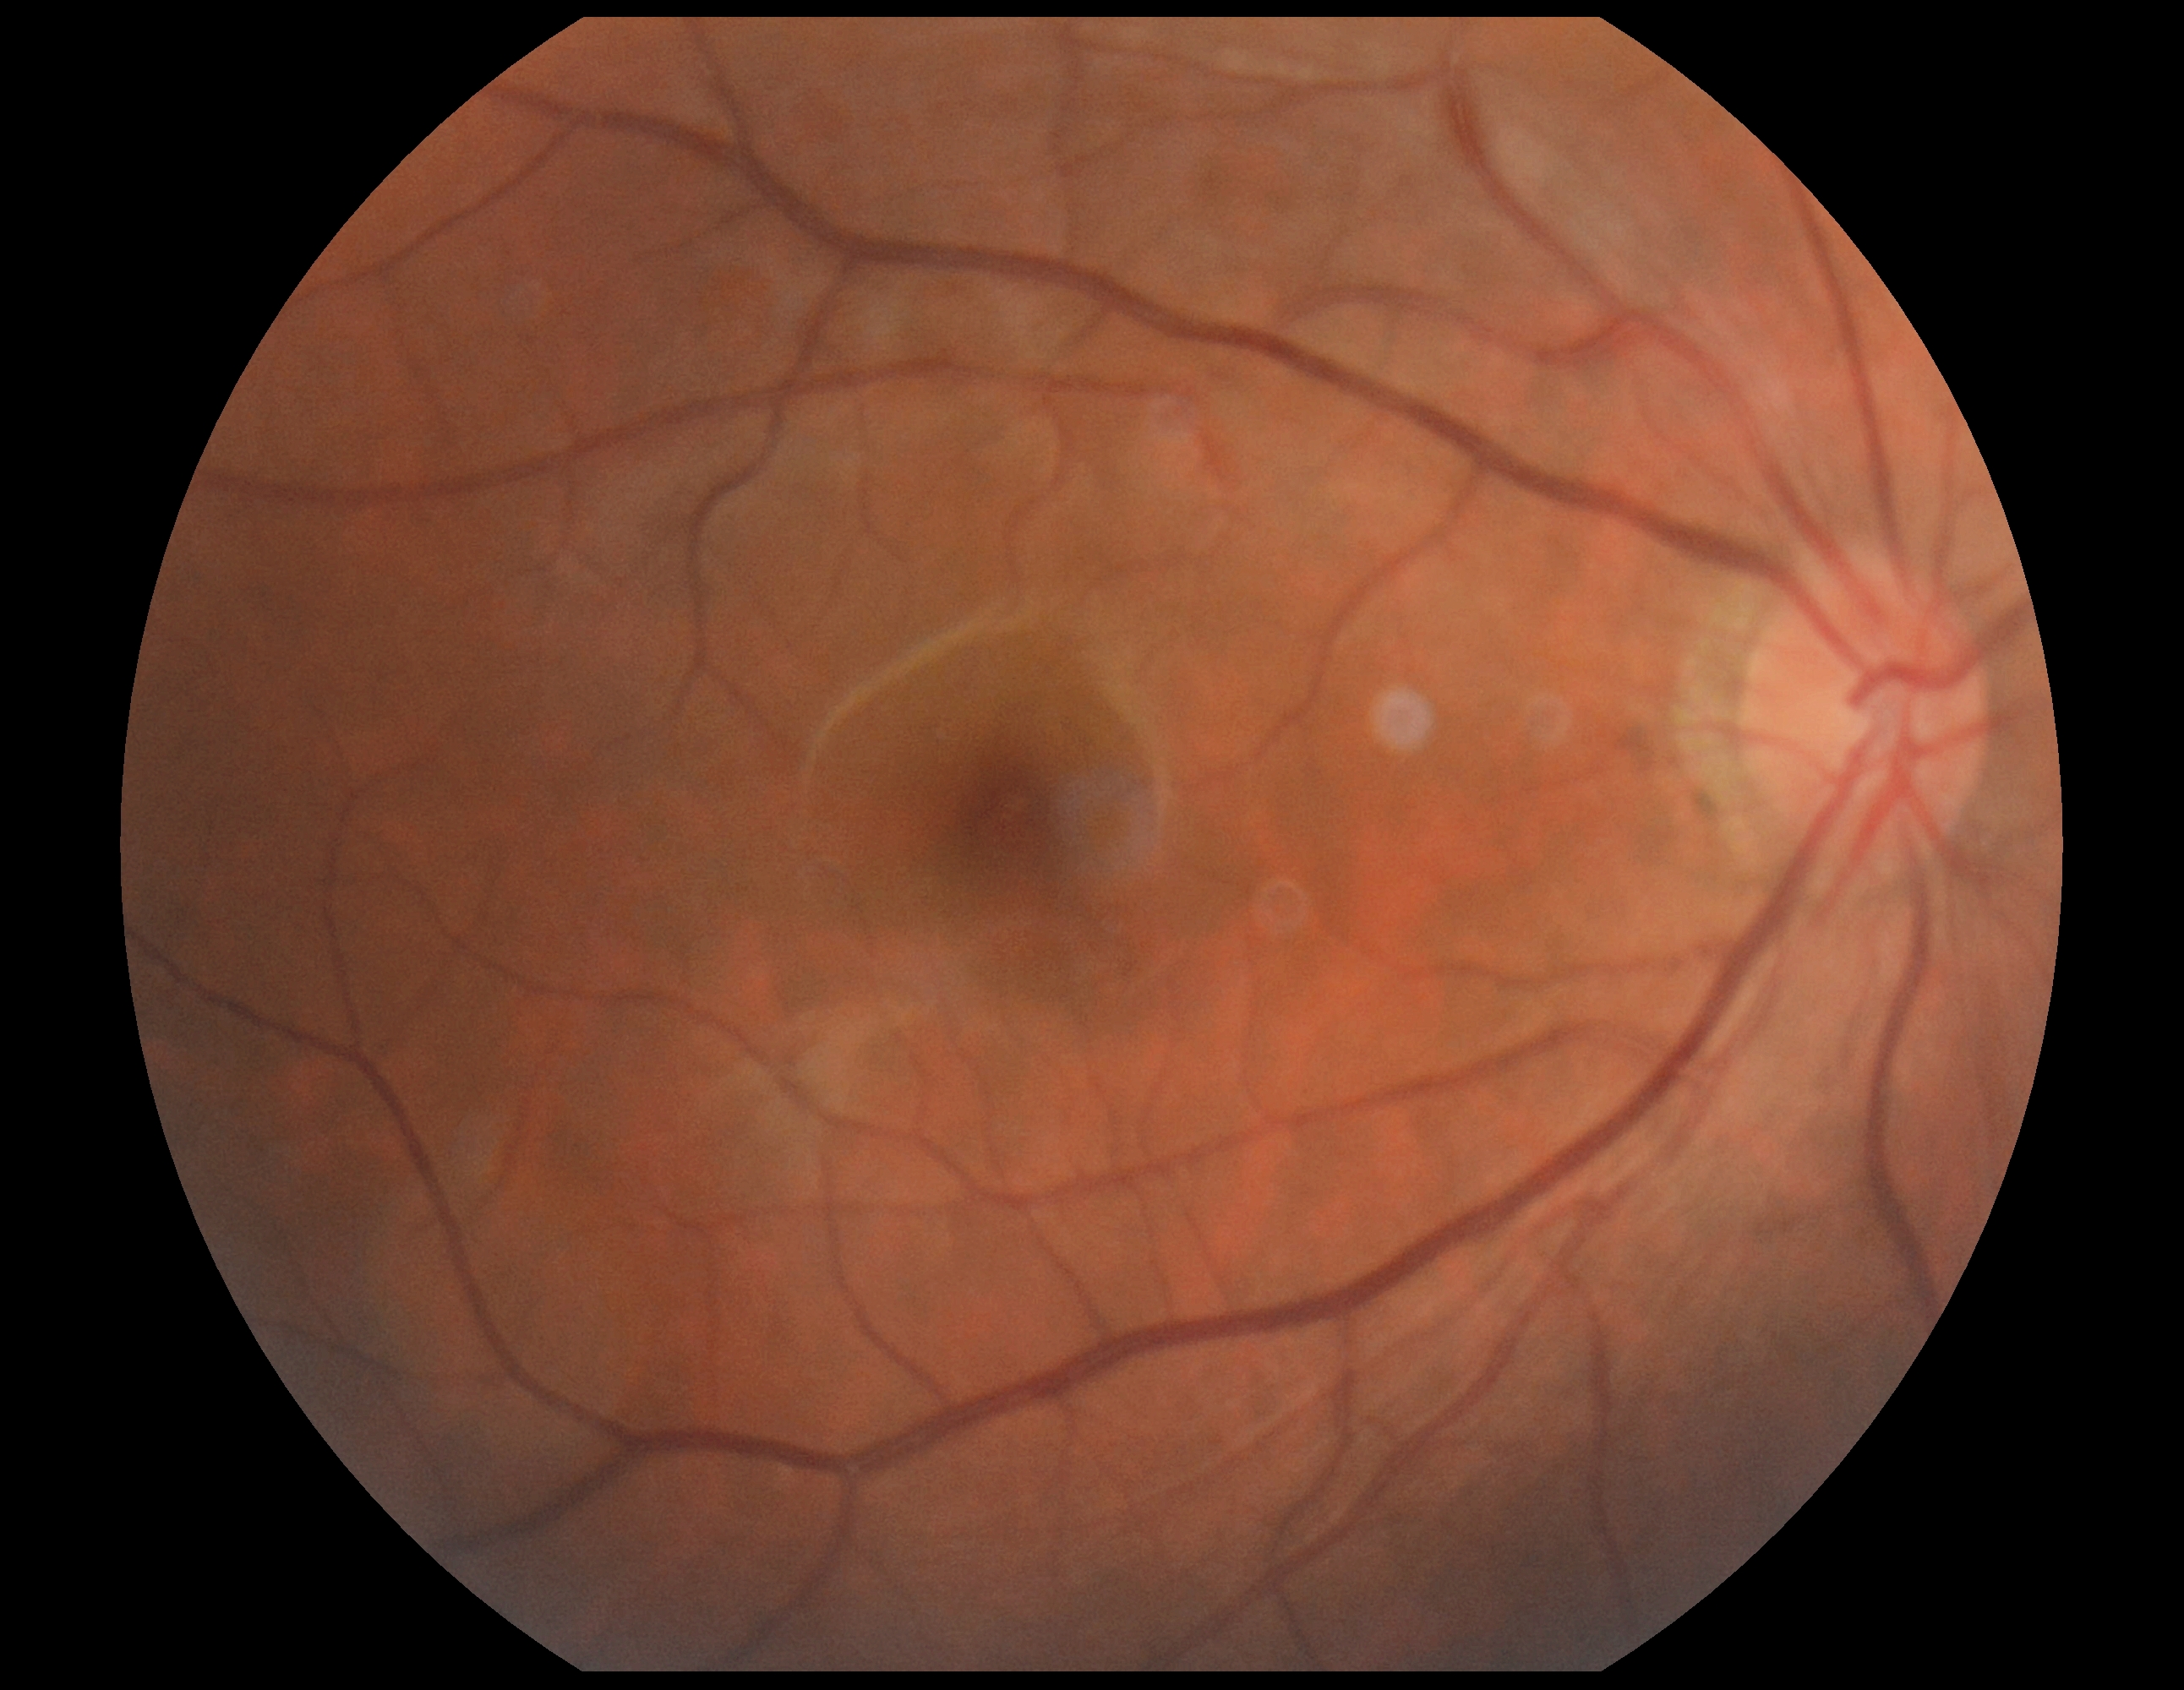
{
  "dr_grade": "no apparent retinopathy (grade 0) — no visible signs of diabetic retinopathy"
}